NIDEK AFC-230. Modified Davis grading. 848x848. Nonmydriatic:
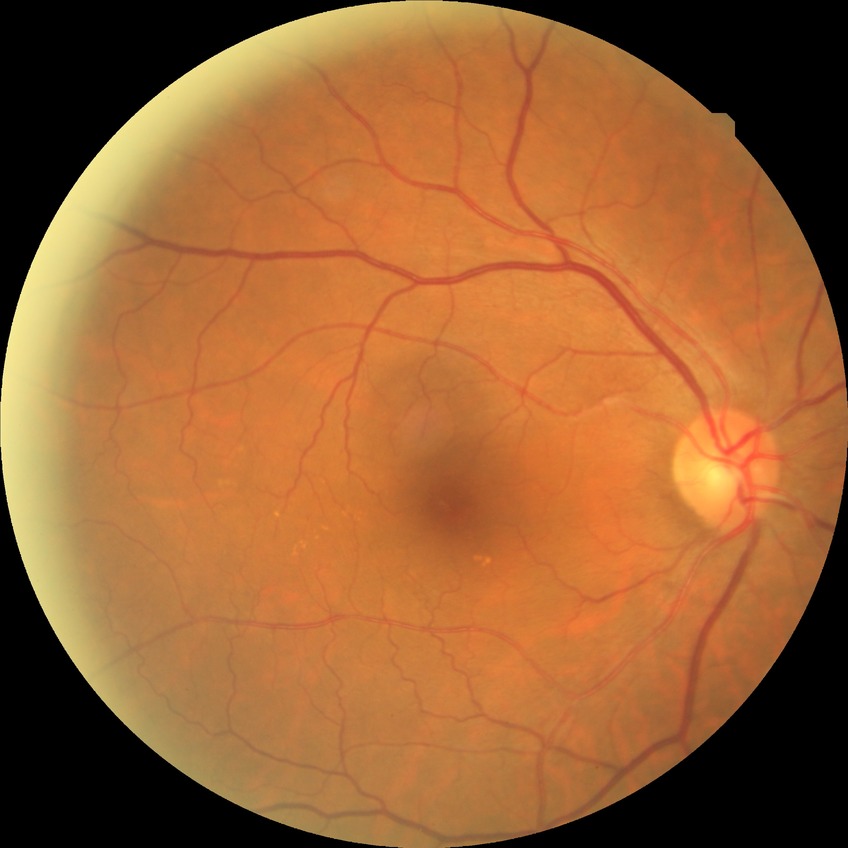
modified Davis grade=NDR.